Camera: NIDEK AFC-230. No pharmacologic dilation: 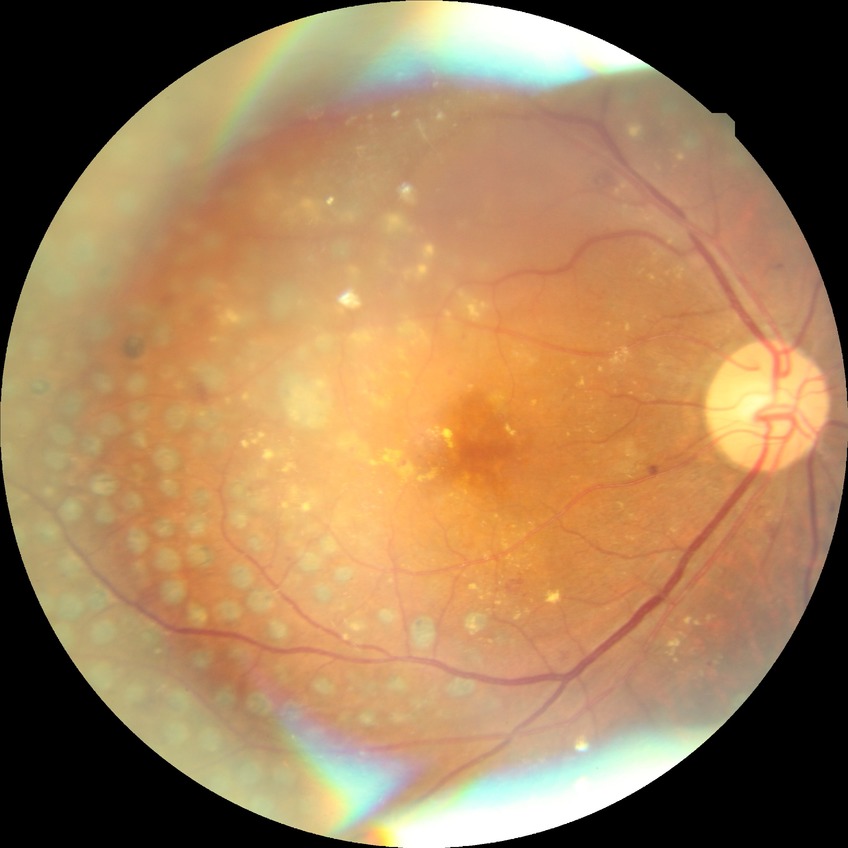 Diabetic retinopathy grade: proliferative diabetic retinopathy.